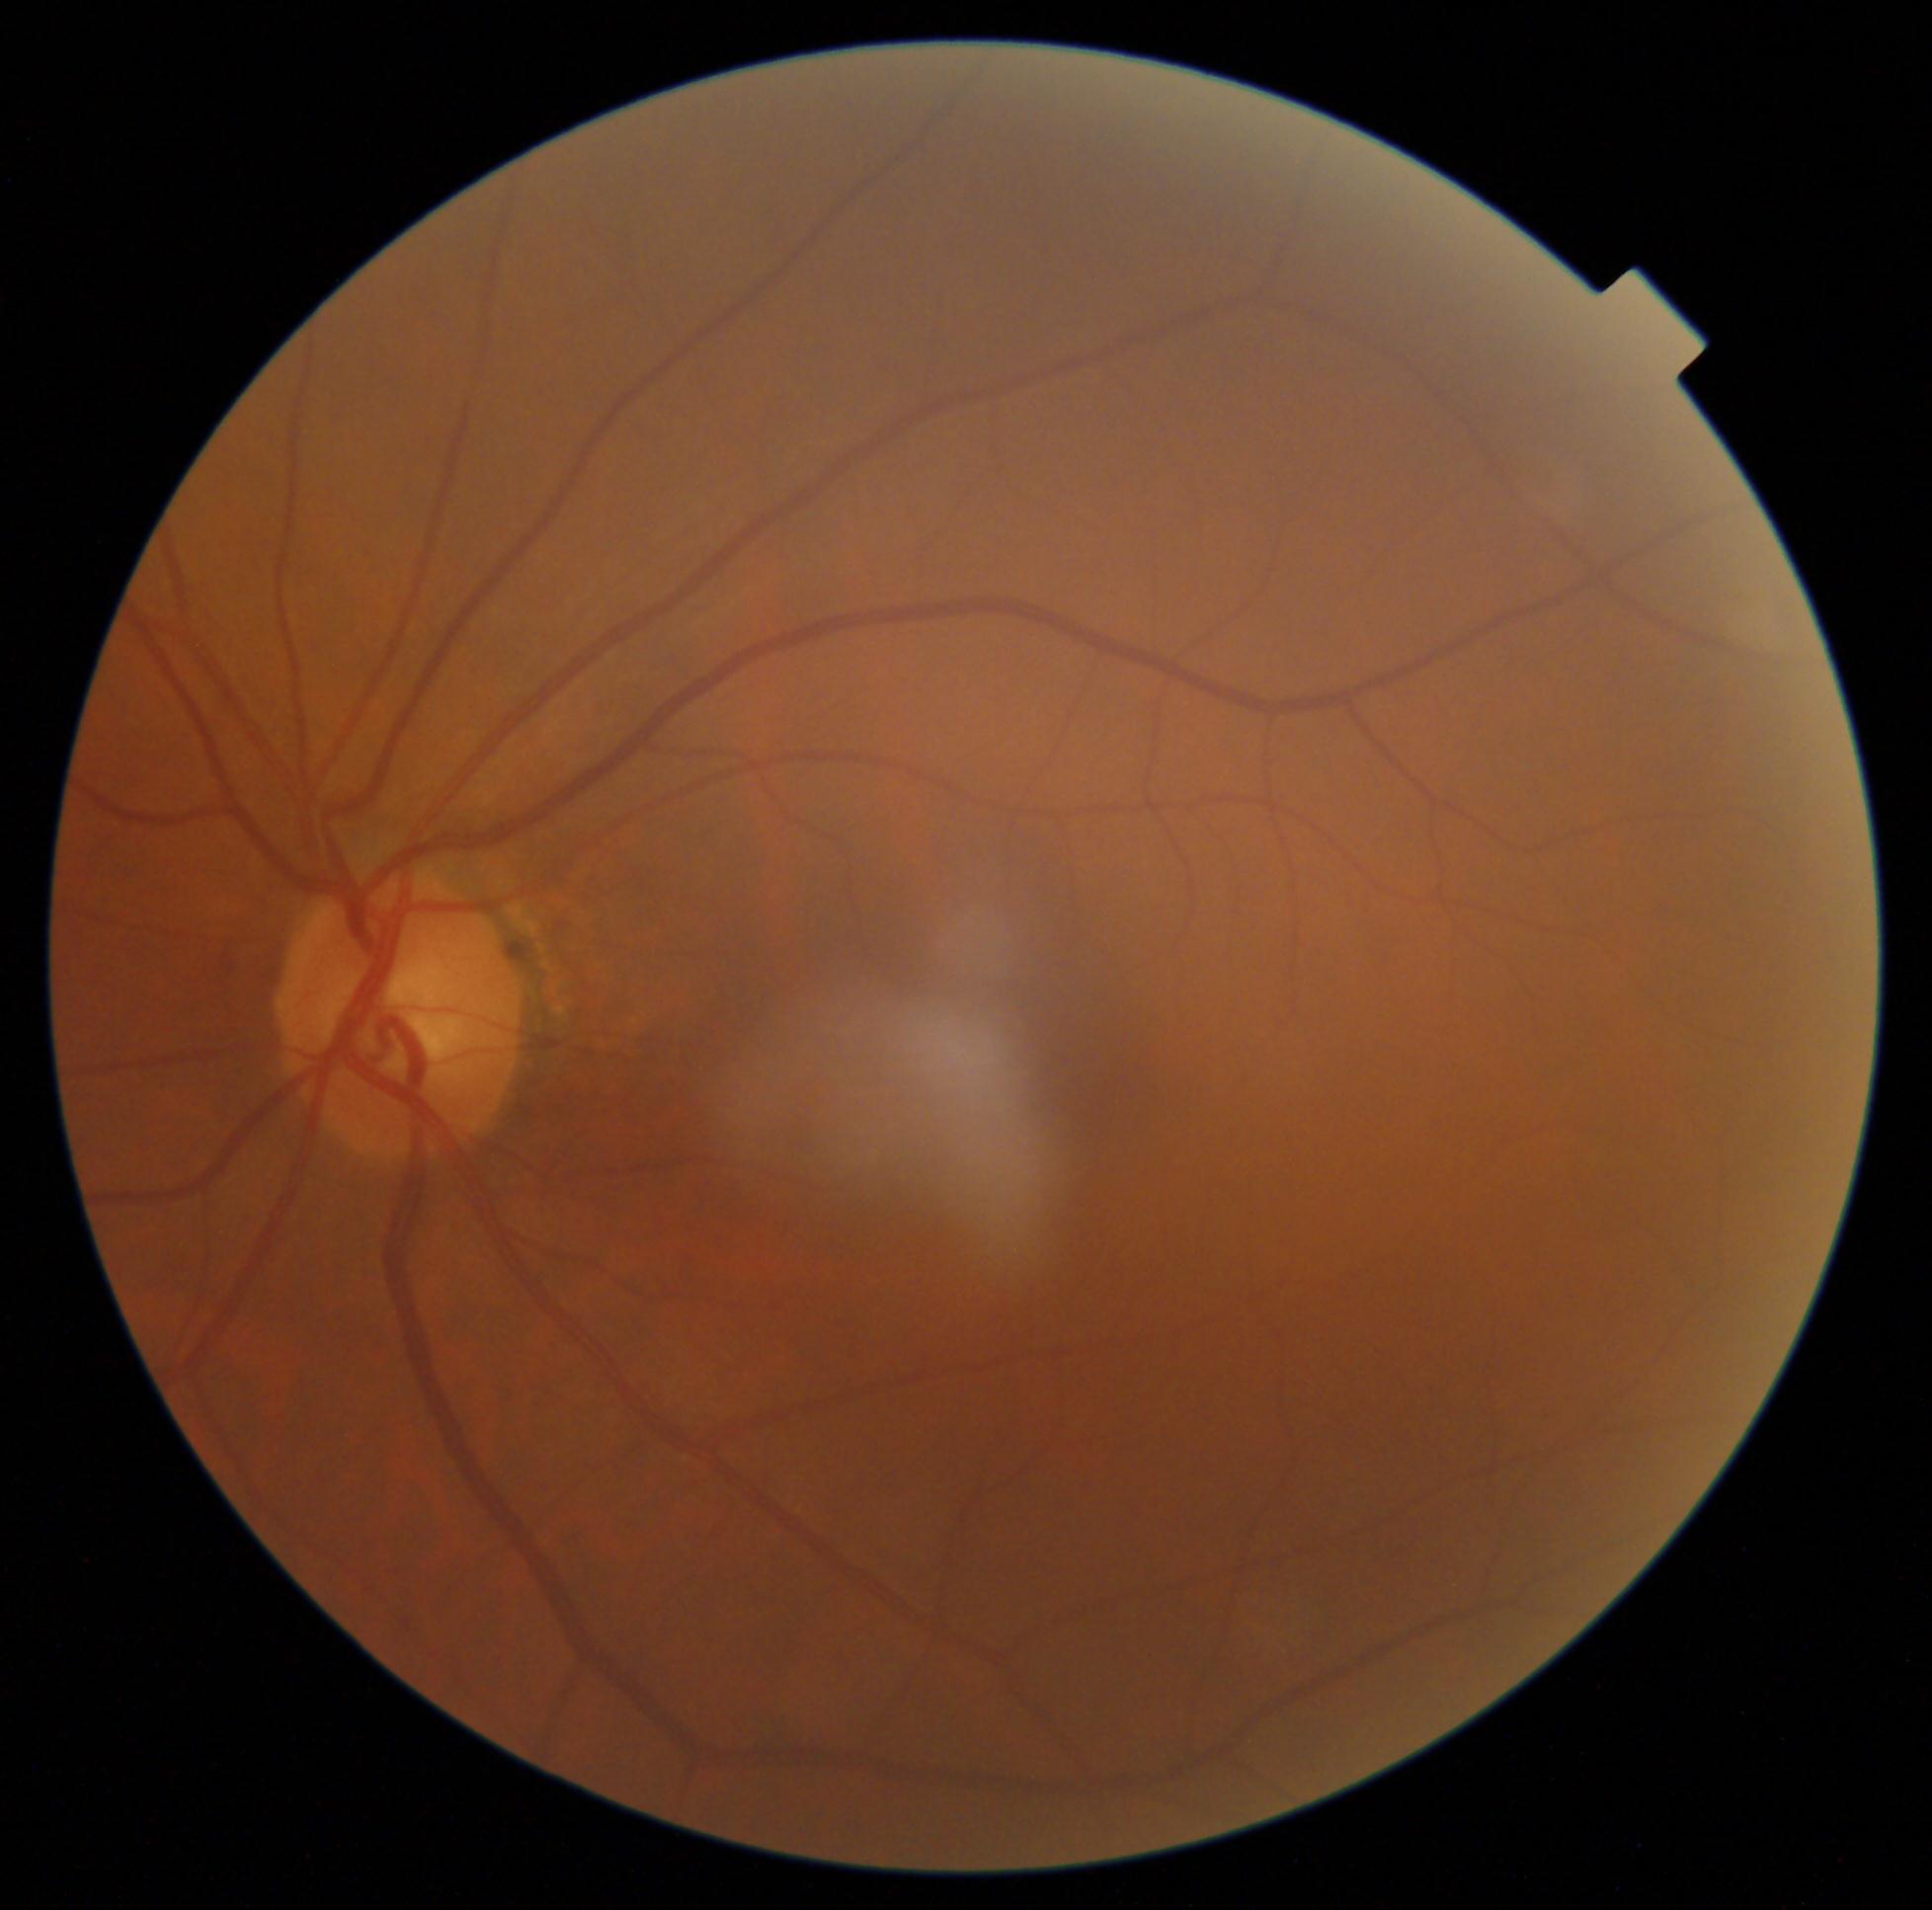 Diabetic retinopathy (DR) is grade 0 (no apparent retinopathy). No signs of diabetic retinopathy.